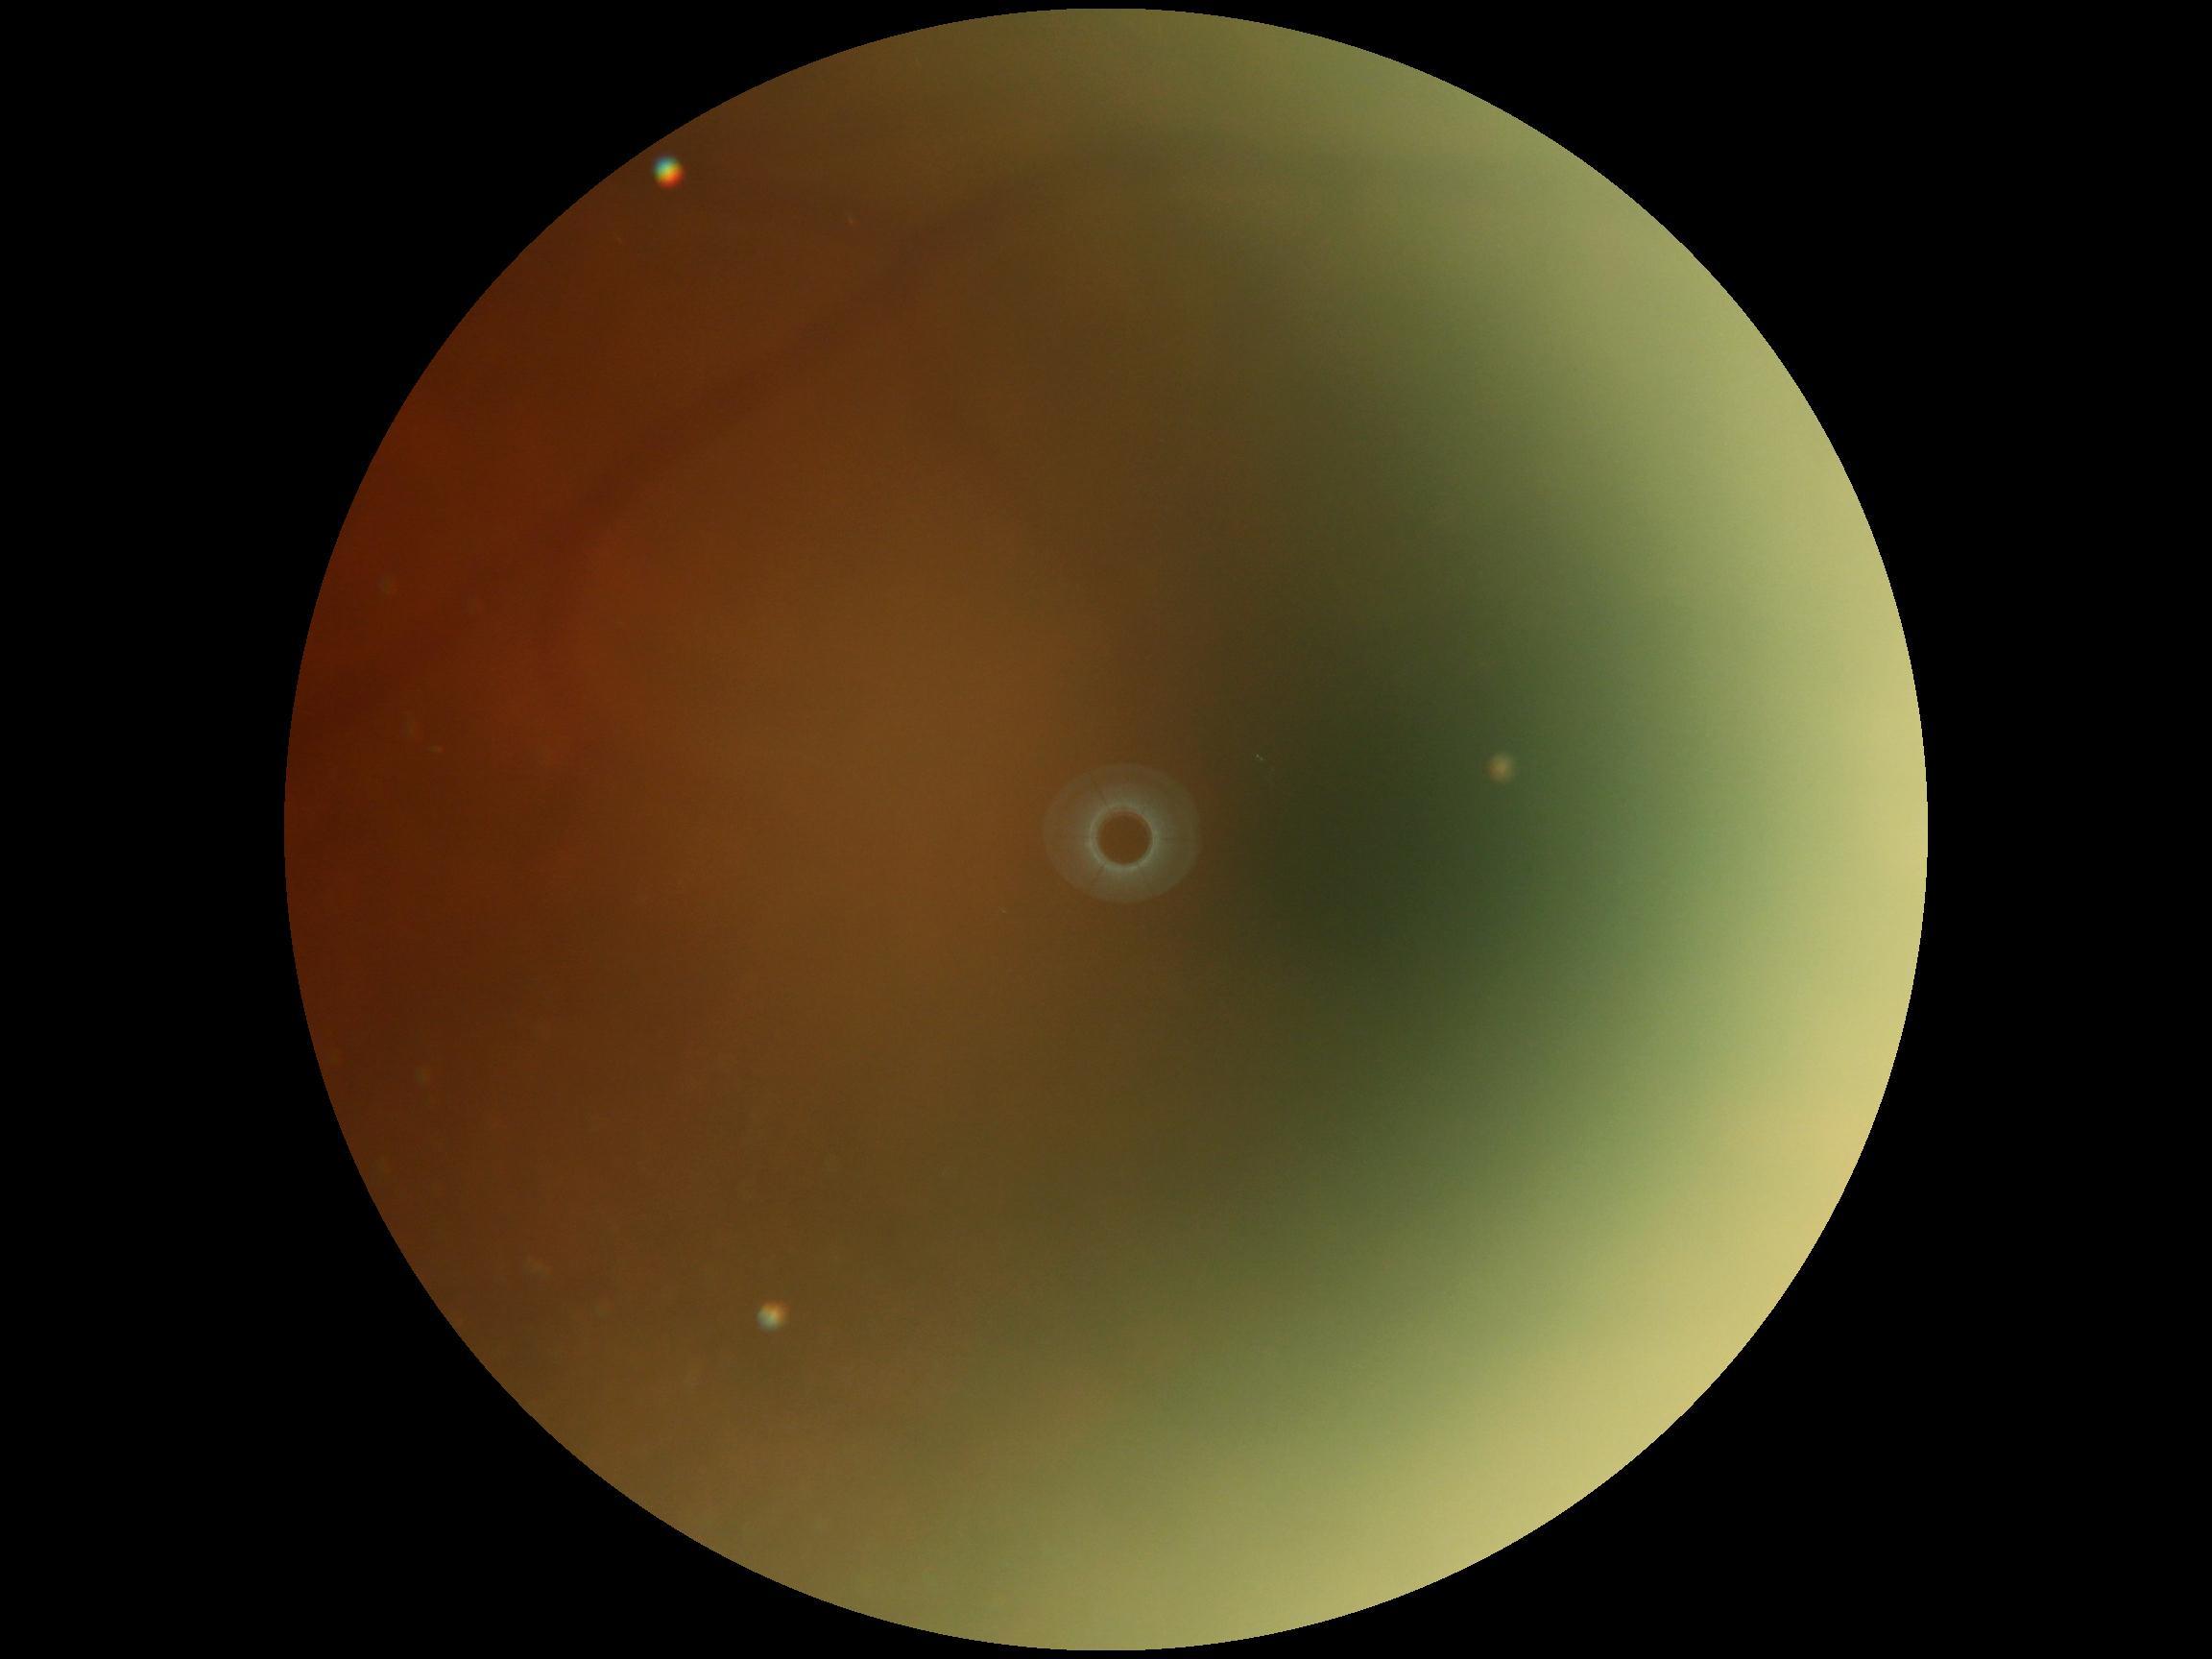

DR: ungradable due to poor image quality